Pediatric wide-field fundus photograph.
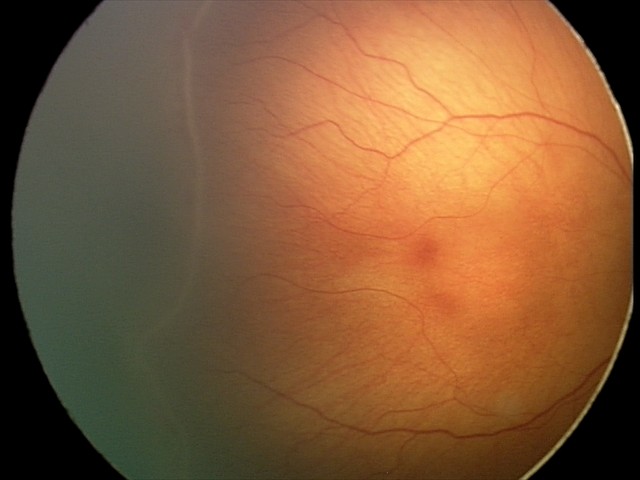 Assessment: retinopathy of prematurity stage 2.